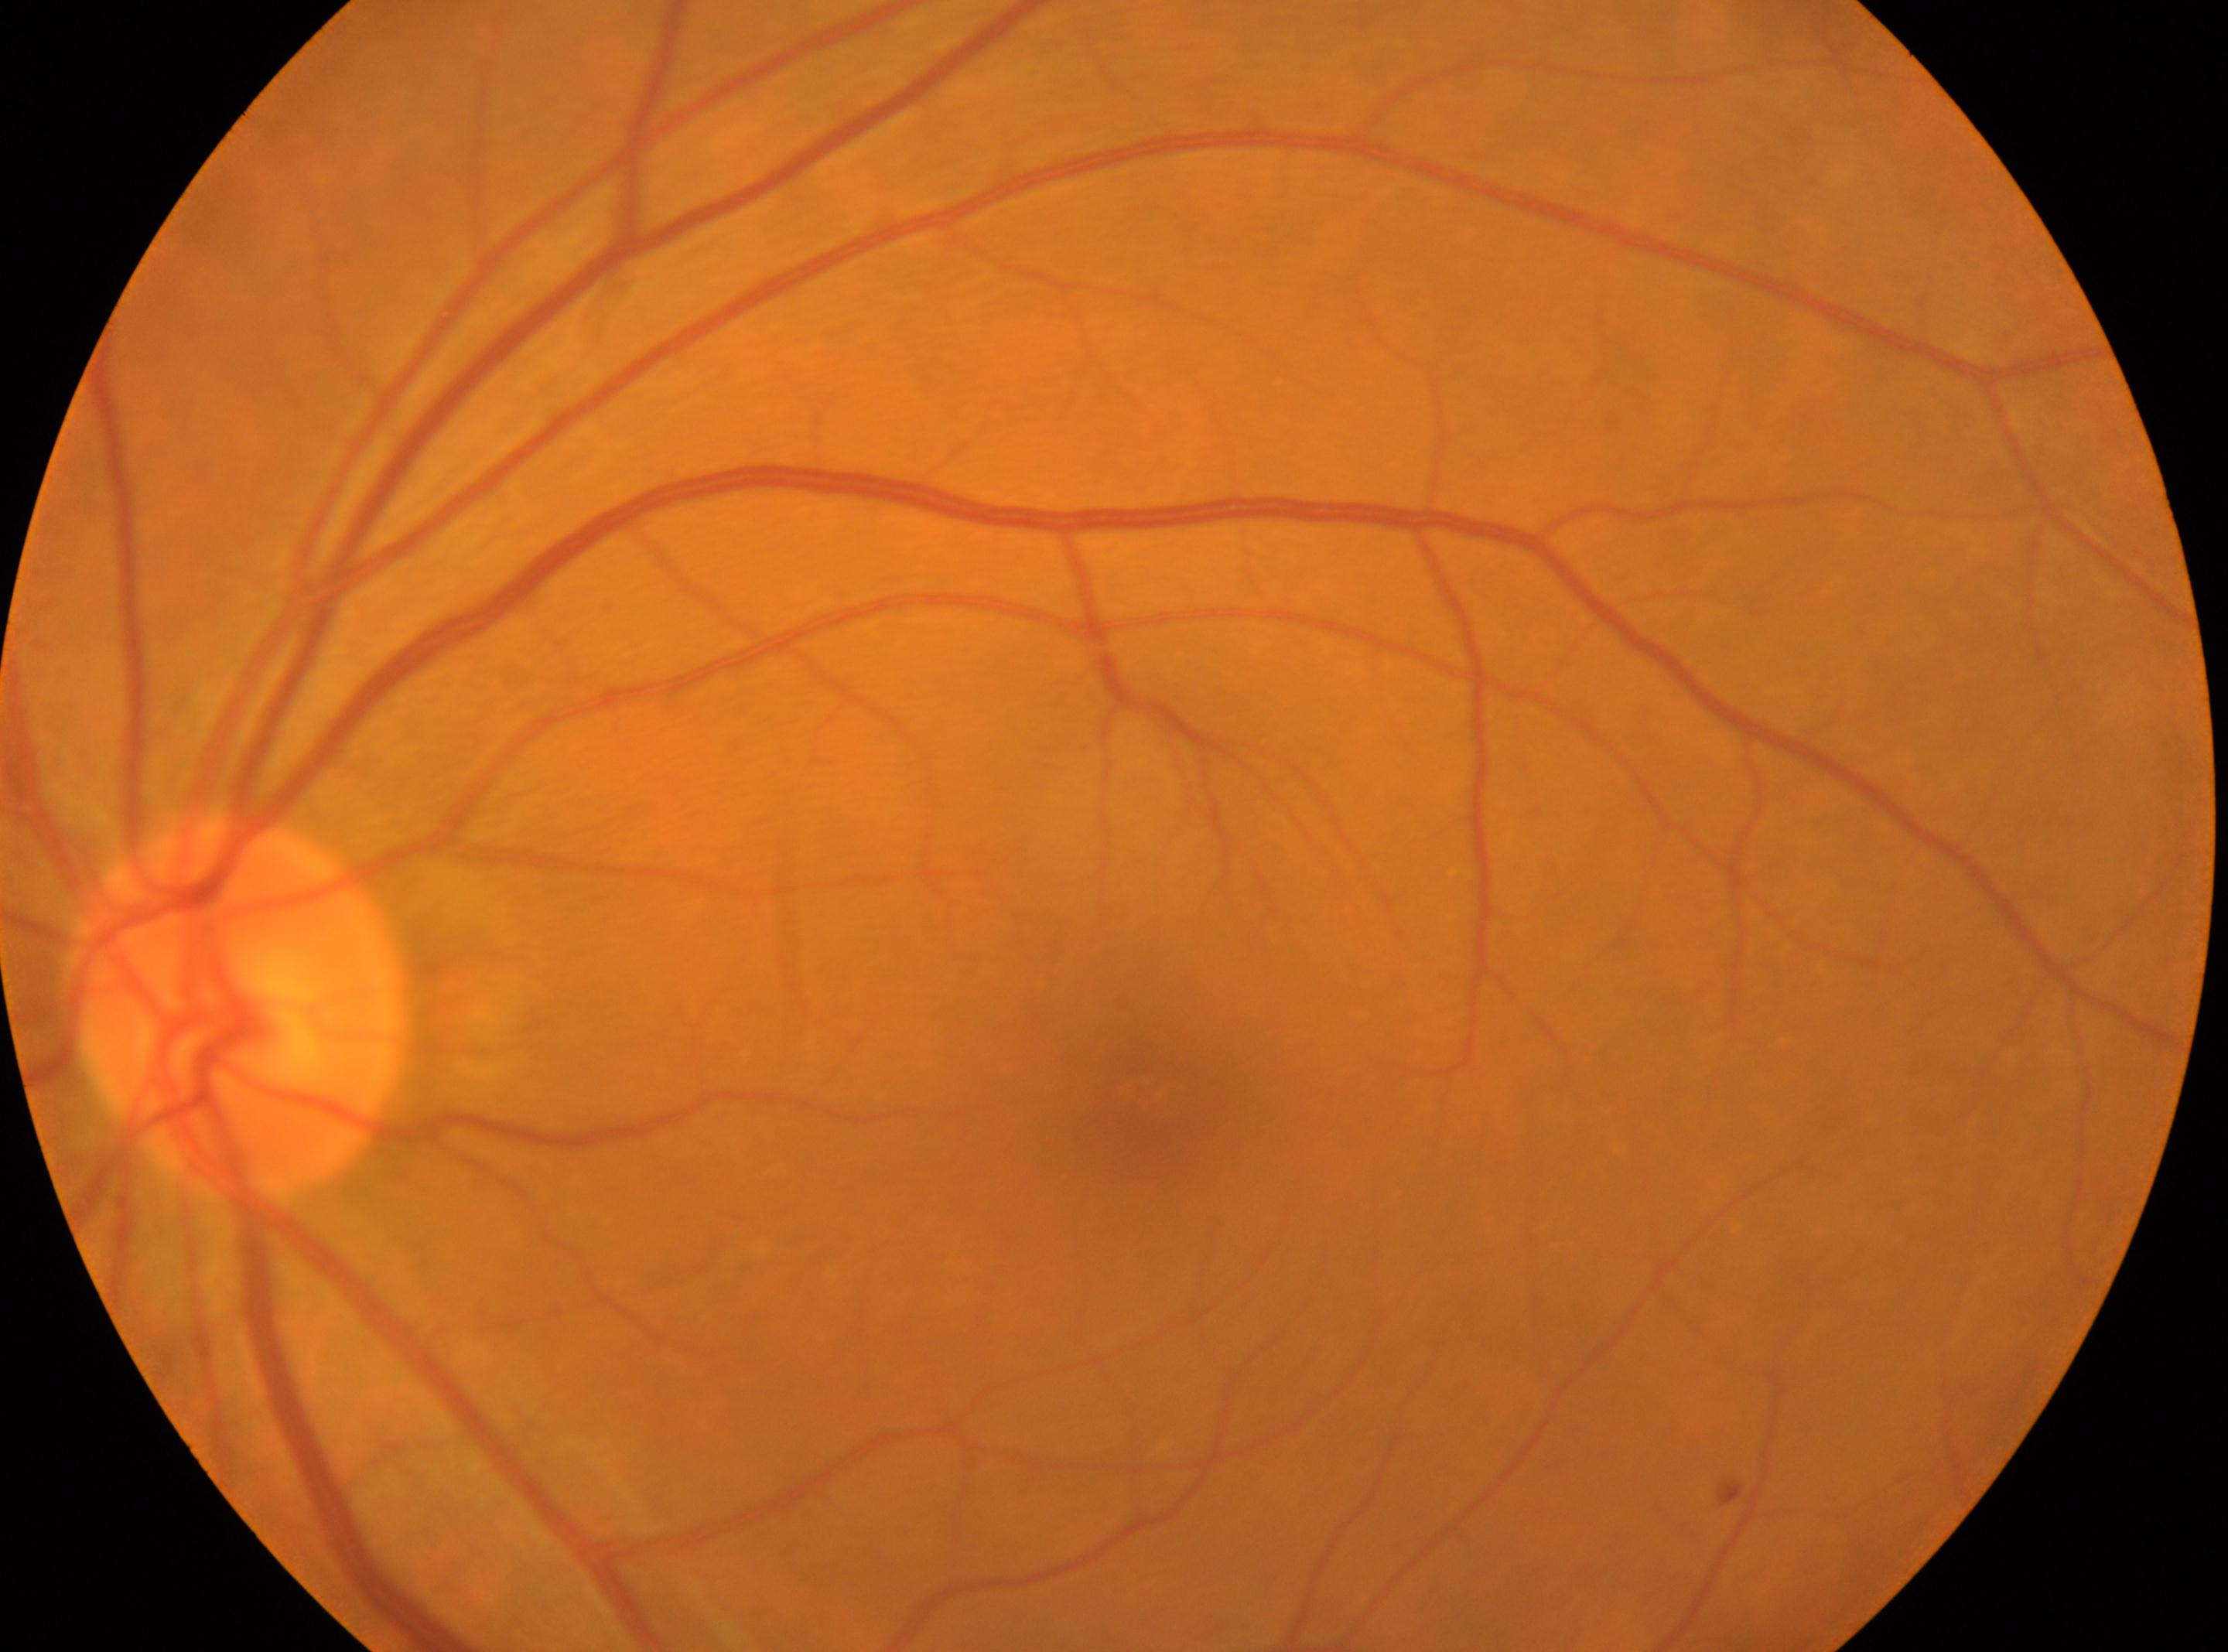
the optic disc = [240, 1007] | retinopathy = no apparent retinopathy (grade 0) | laterality = left | fovea = [1145, 1091].